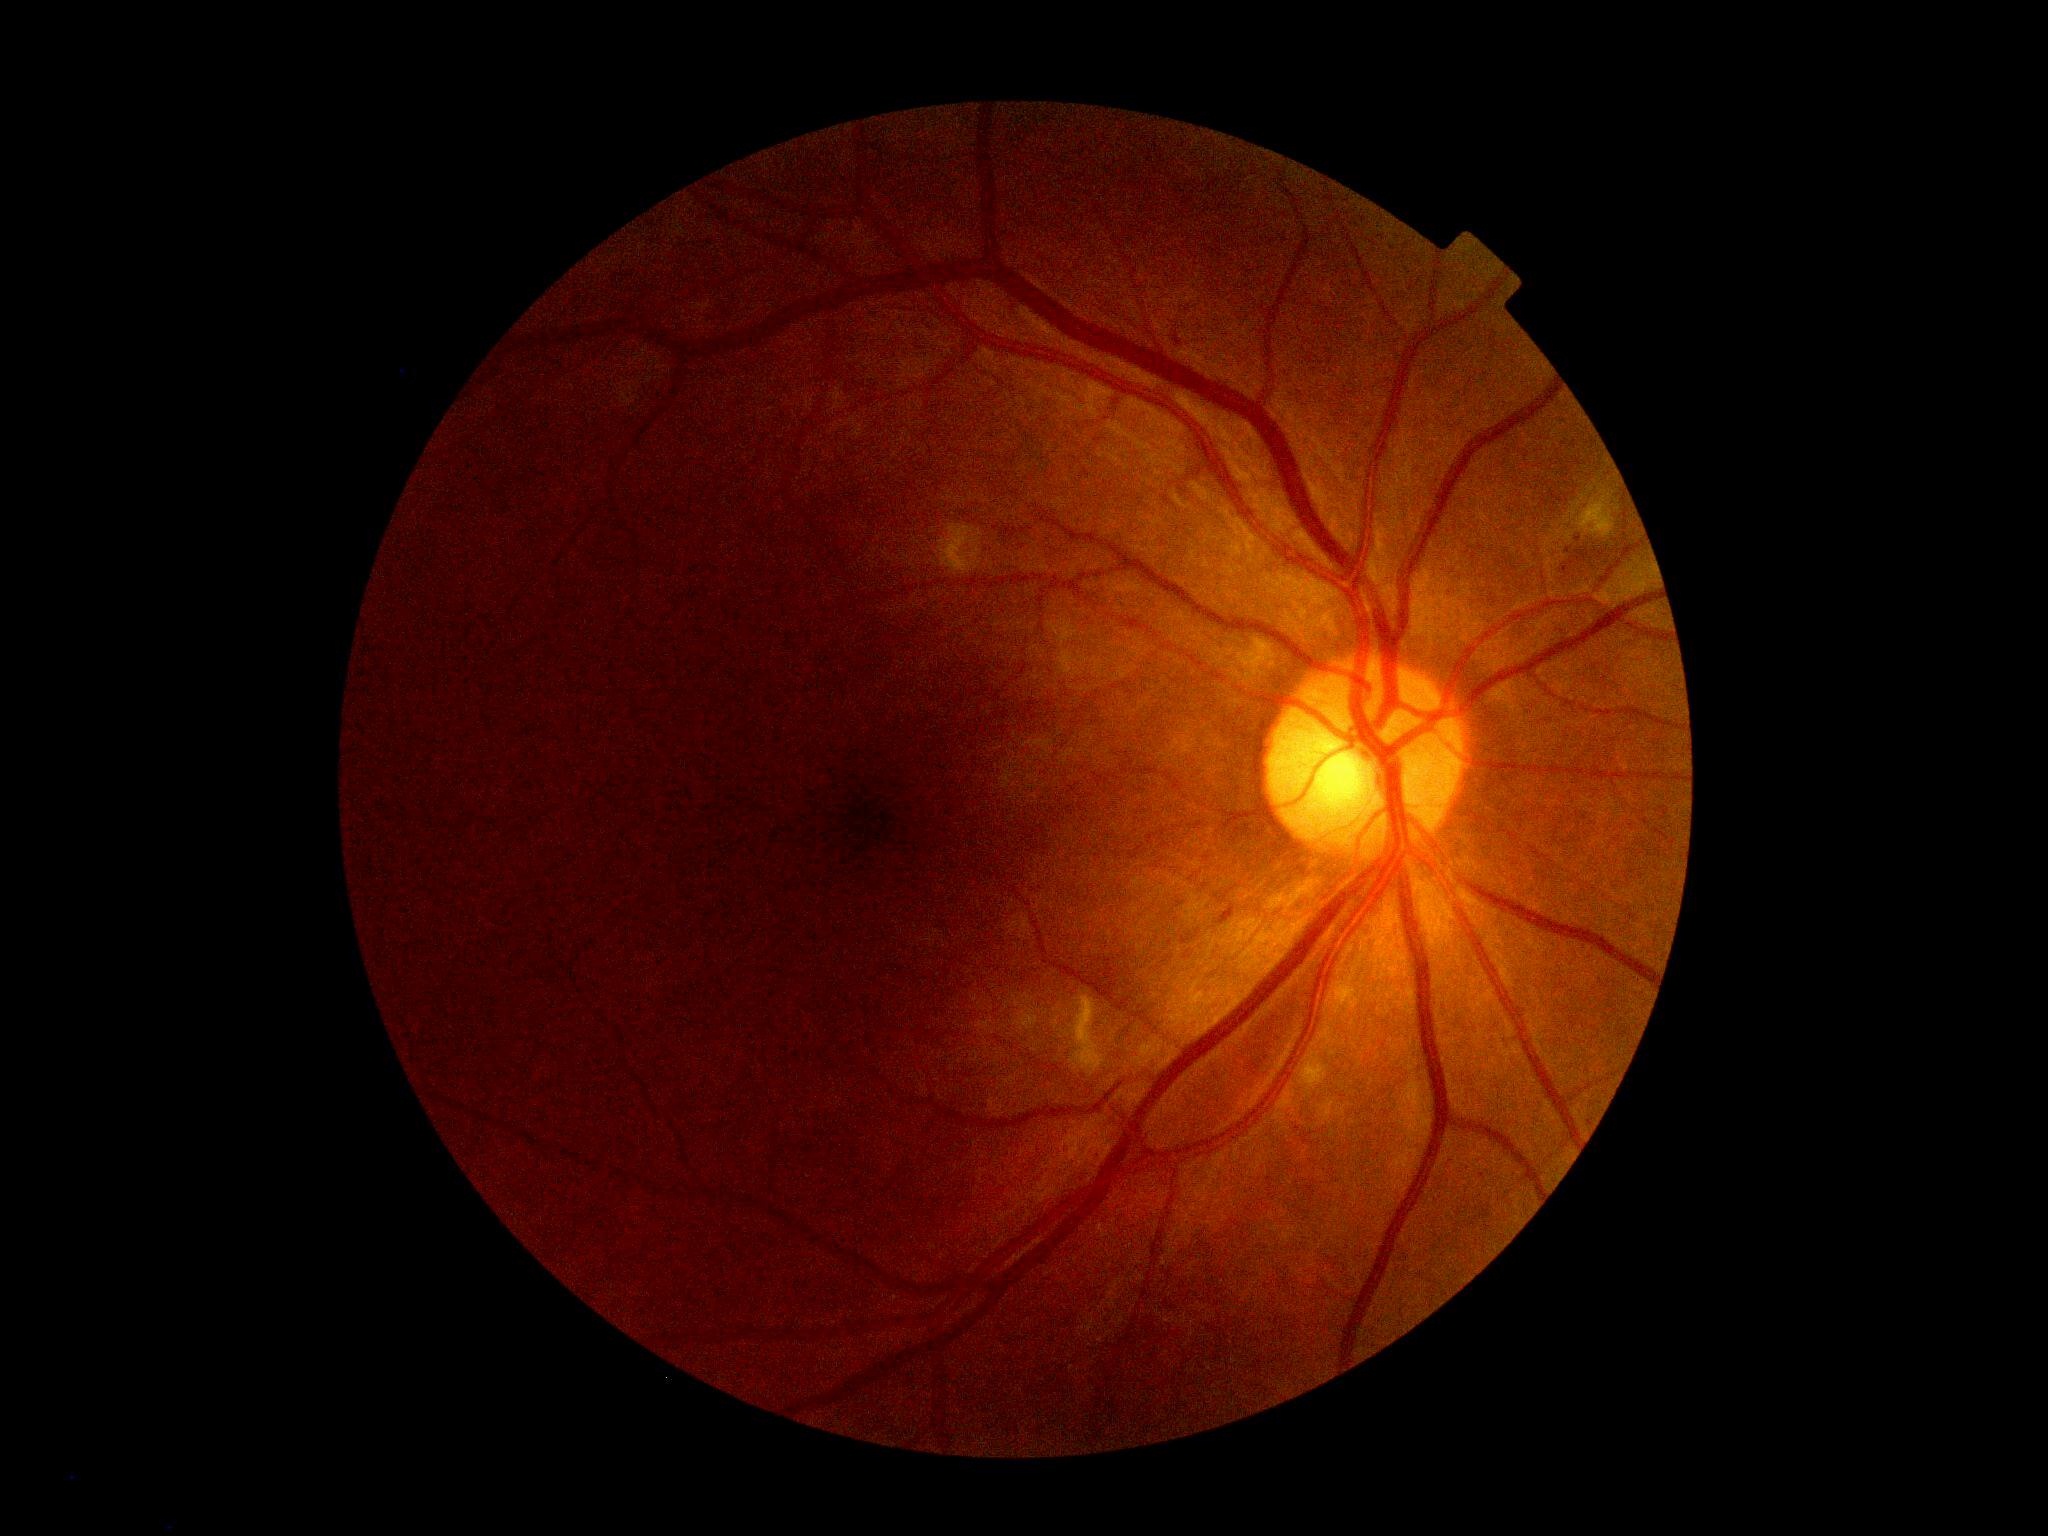
{
  "dr_grade": "2/4"
}